1536 x 1152 pixels. 45-degree field of view
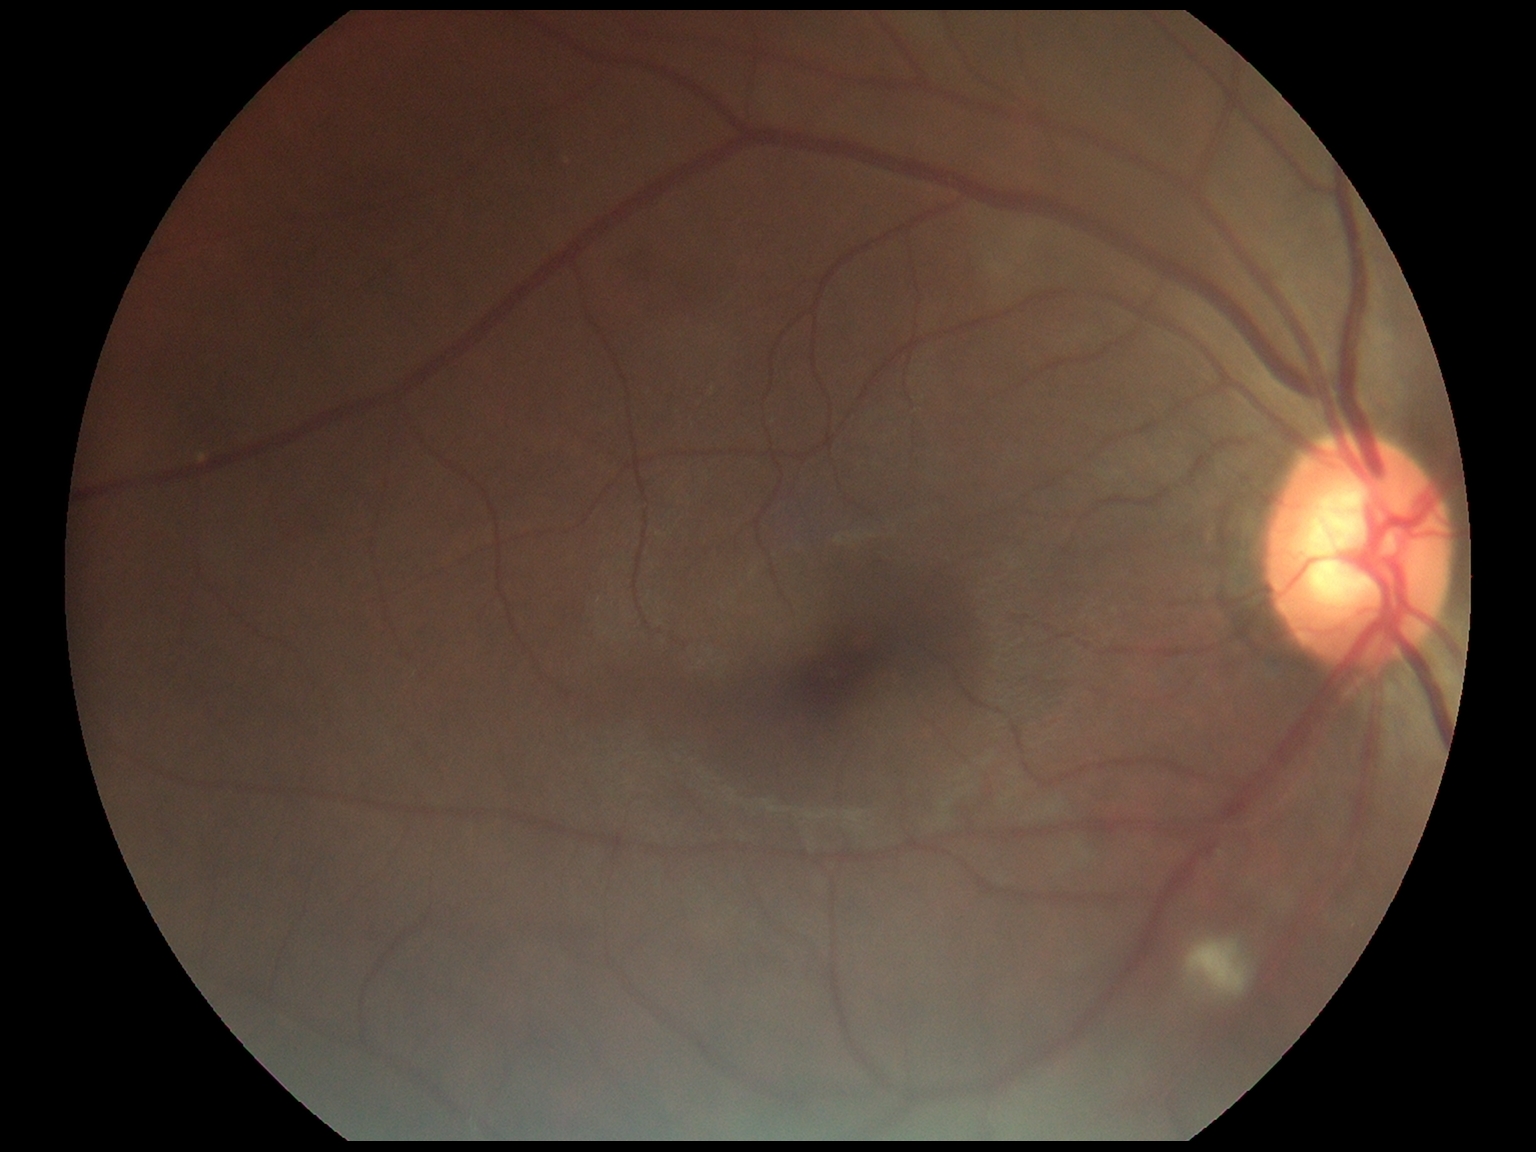 Findings:
* DR class — non-proliferative diabetic retinopathy
* diabetic retinopathy severity — 2/4